Graded on the modified Davis scale; no pharmacologic dilation; camera: NIDEK AFC-230.
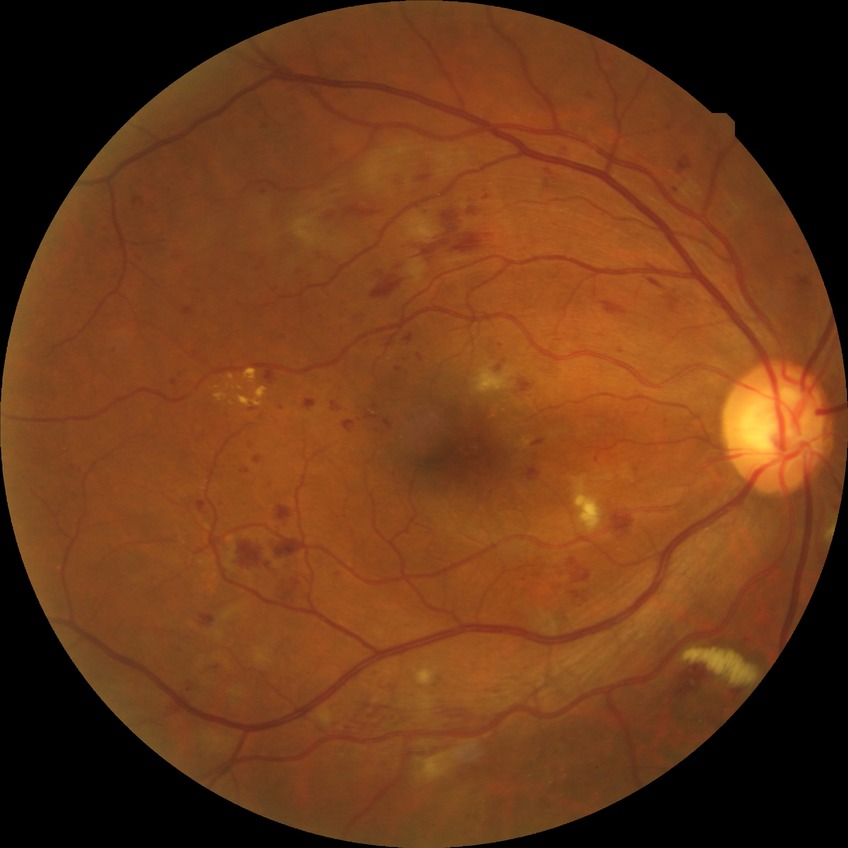
diabetic retinopathy (DR): pre-proliferative diabetic retinopathy (PPDR).